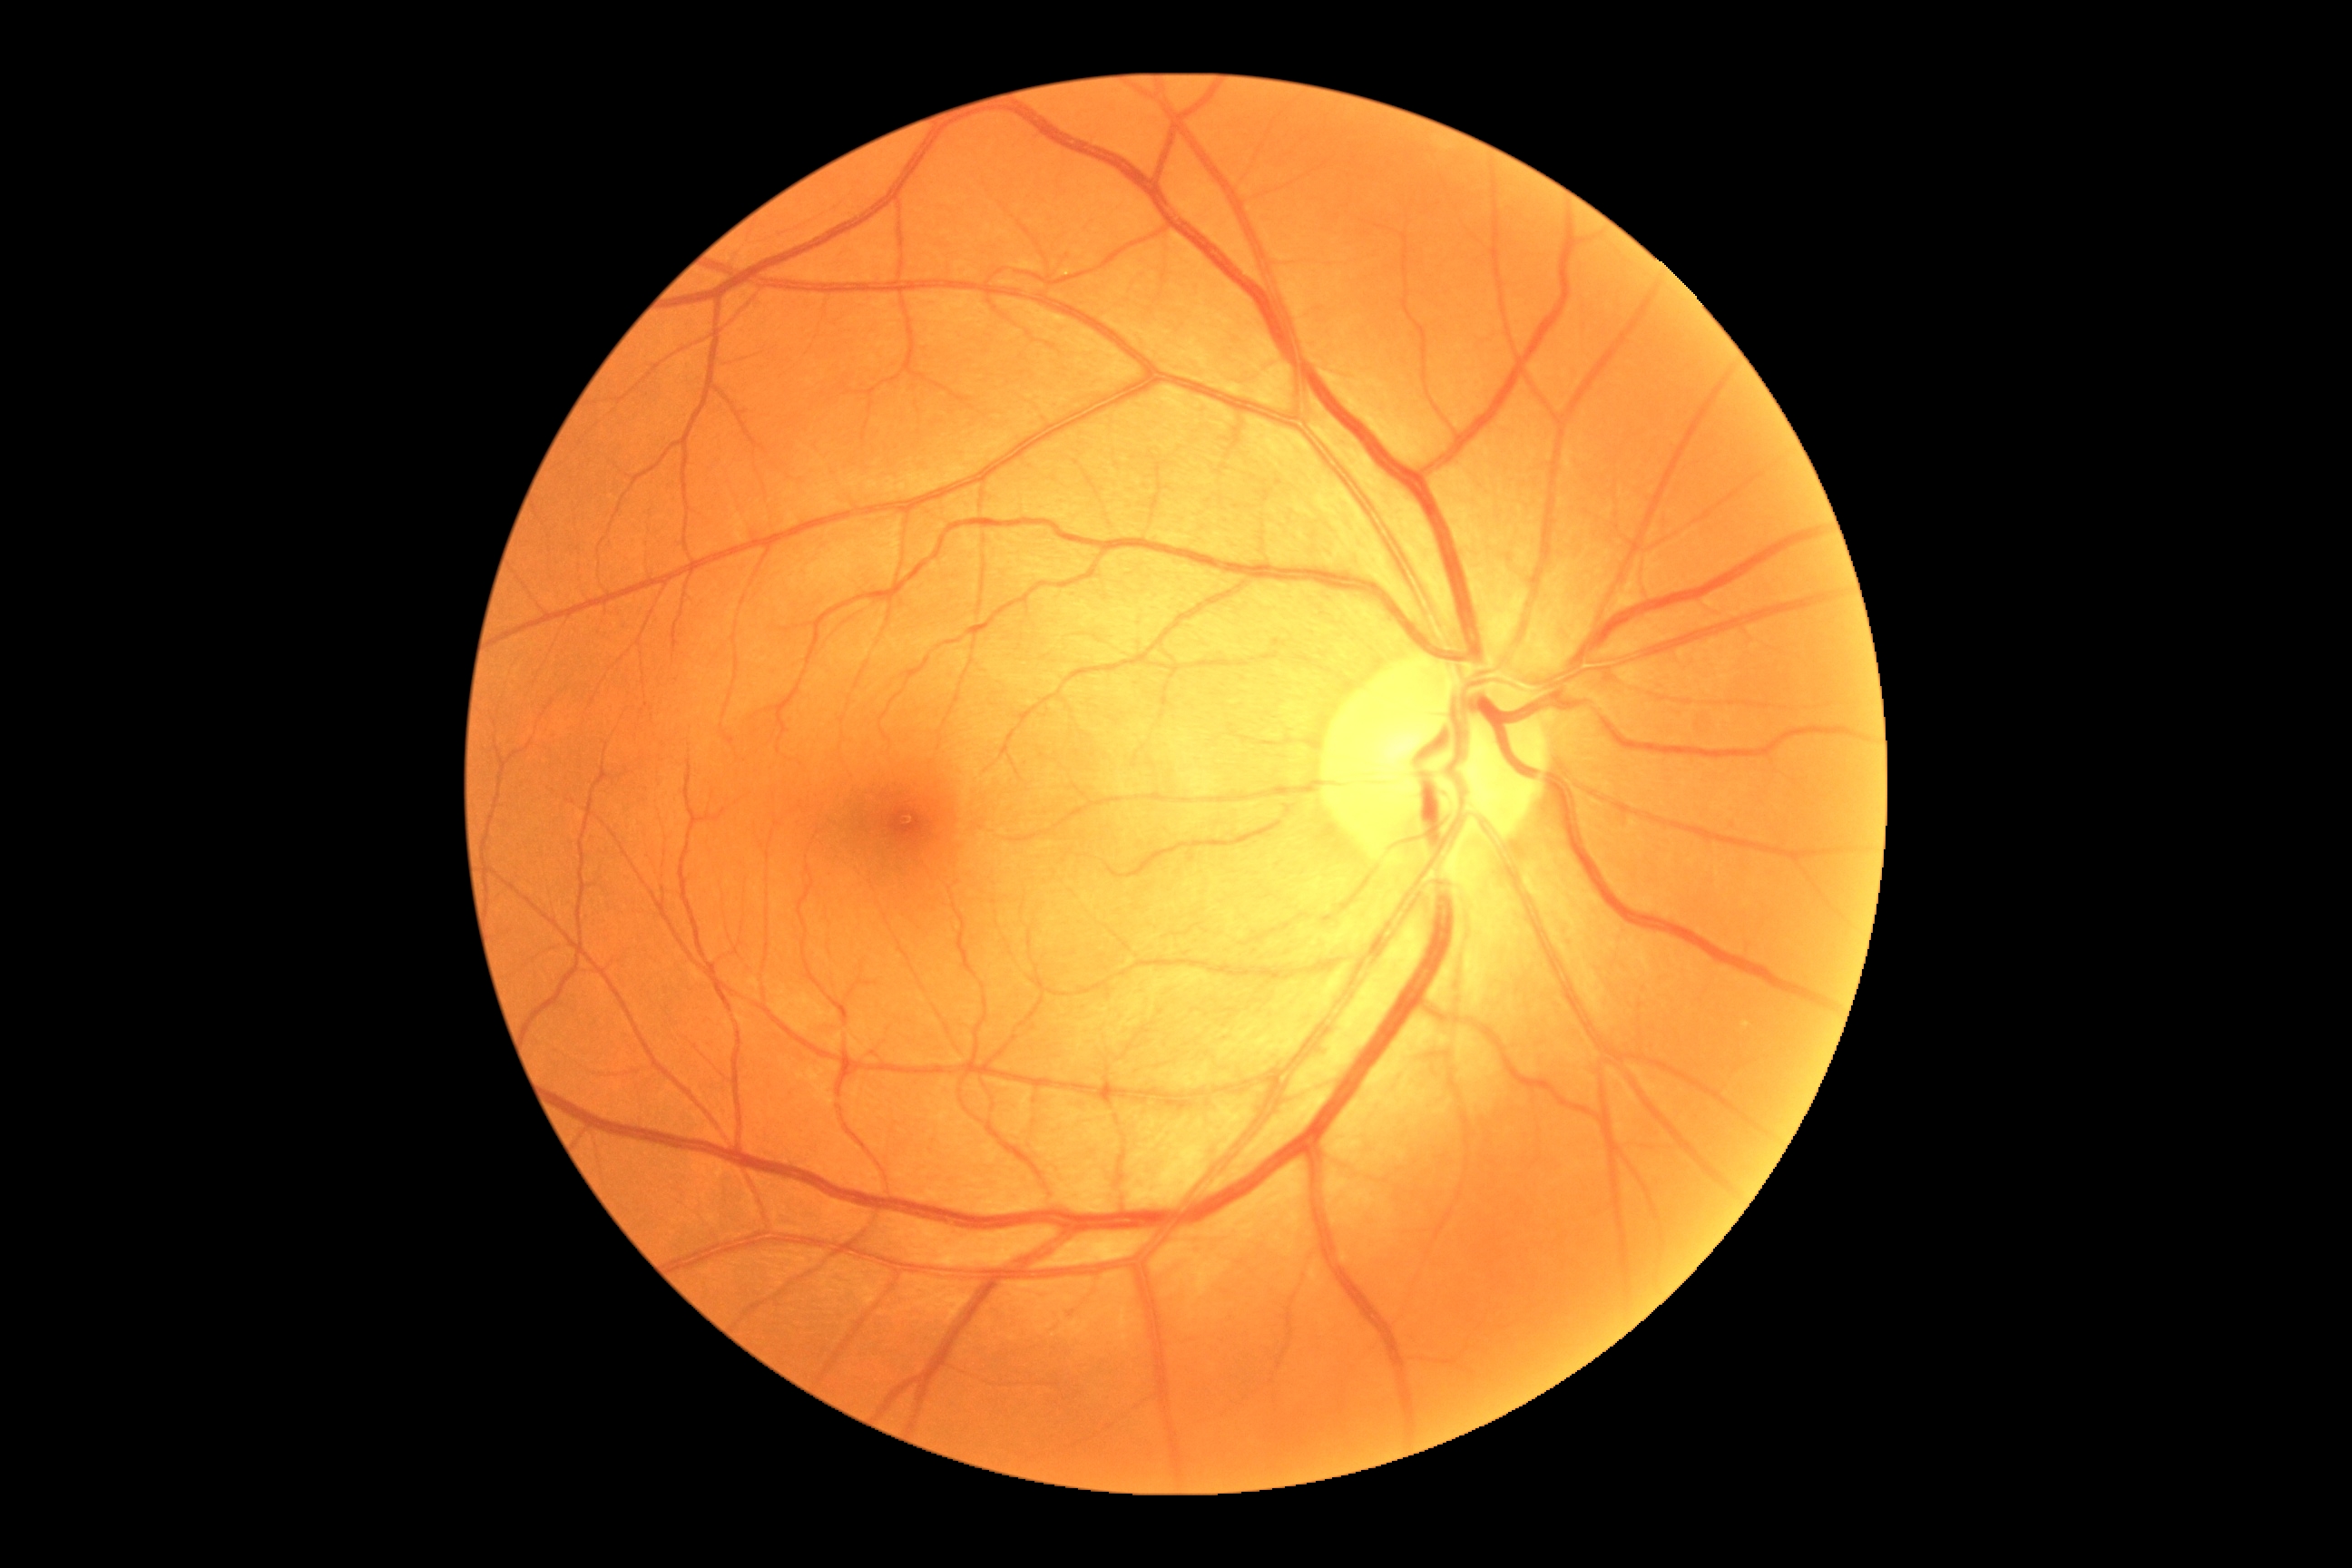 DR = 0/4.